No pharmacologic dilation · 45-degree field of view · posterior pole color fundus photograph · 848 by 848 pixels — 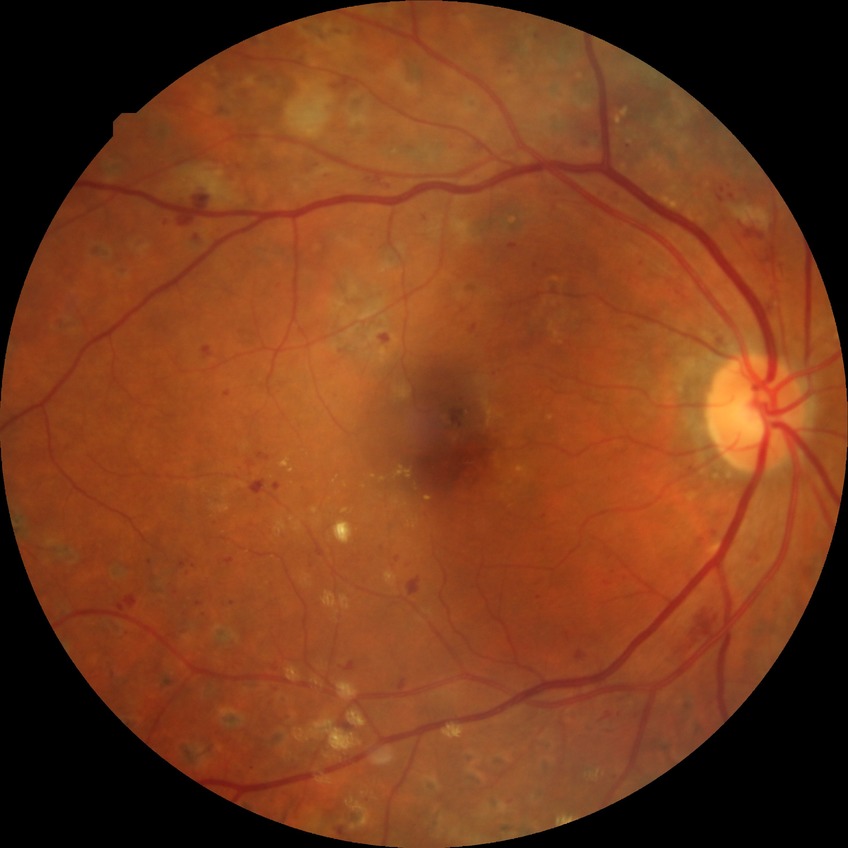 Davis stage is PDR.